1659 by 2212 pixels; color fundus photograph
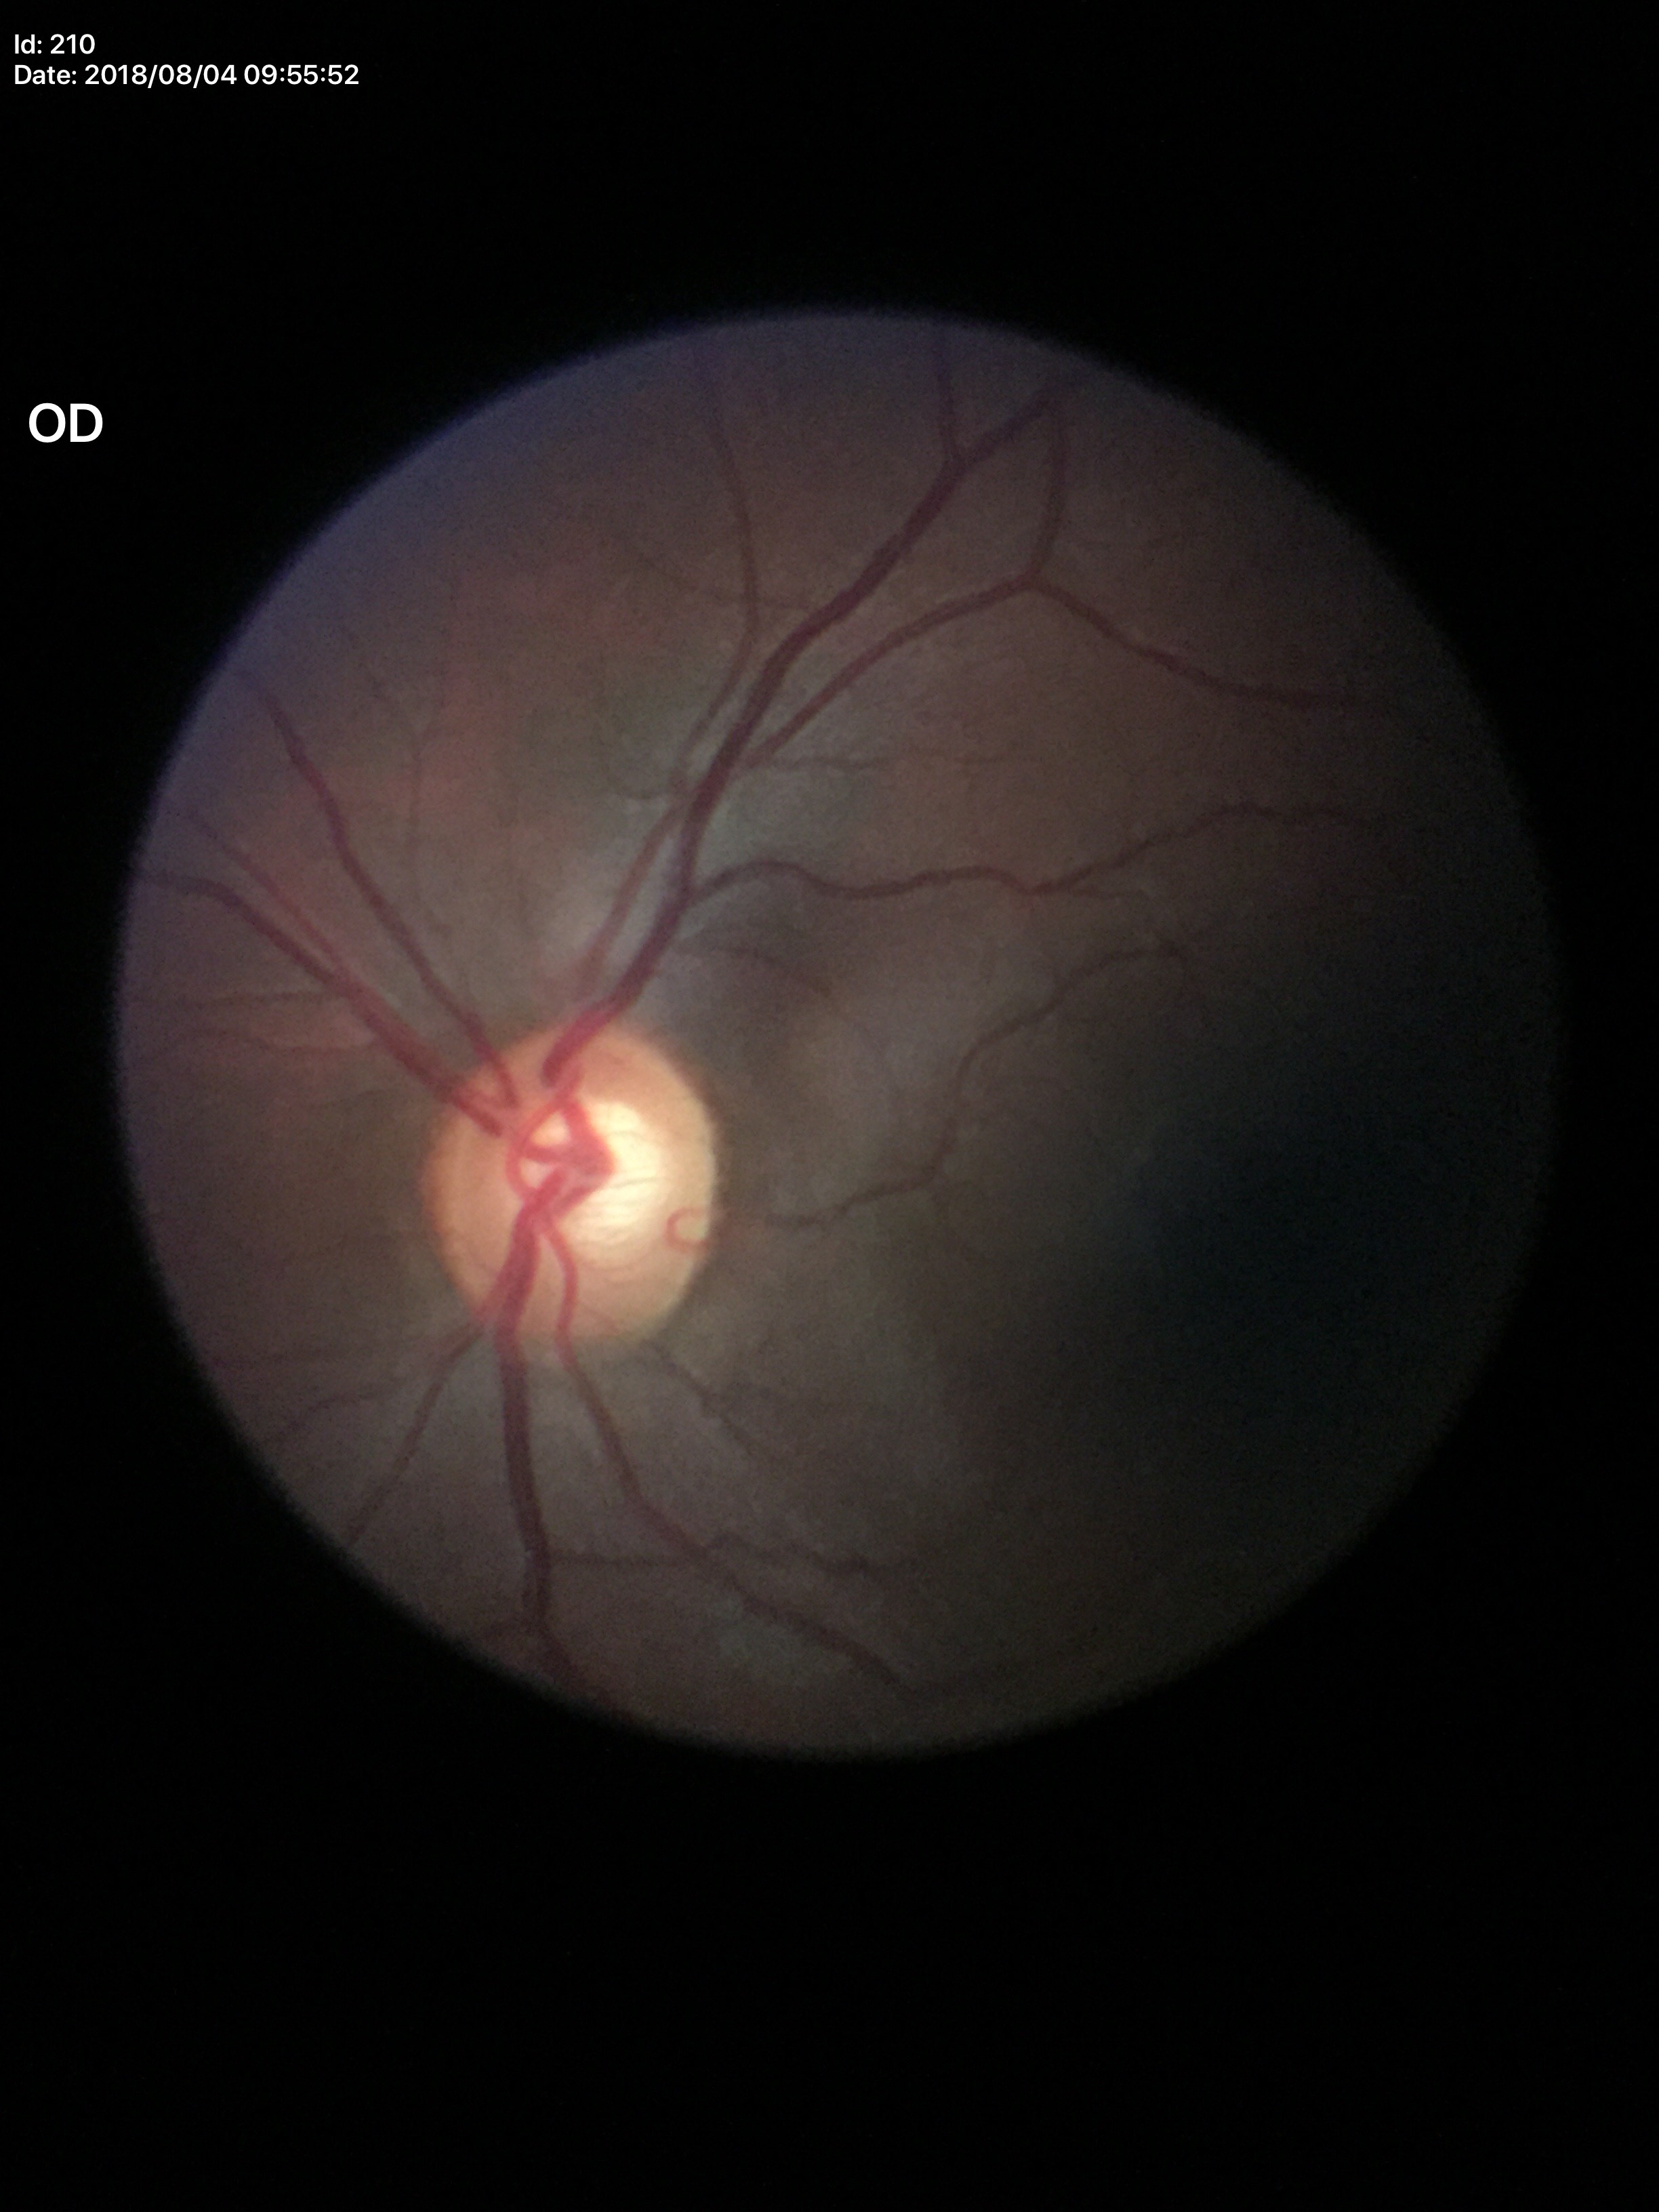 Vertical C/D ratio: 0.59. Horizontal CDR of 0.62. No evidence of glaucoma.